Captured with the Phoenix ICON (100° field of view) · wide-field fundus photograph from neonatal ROP screening: 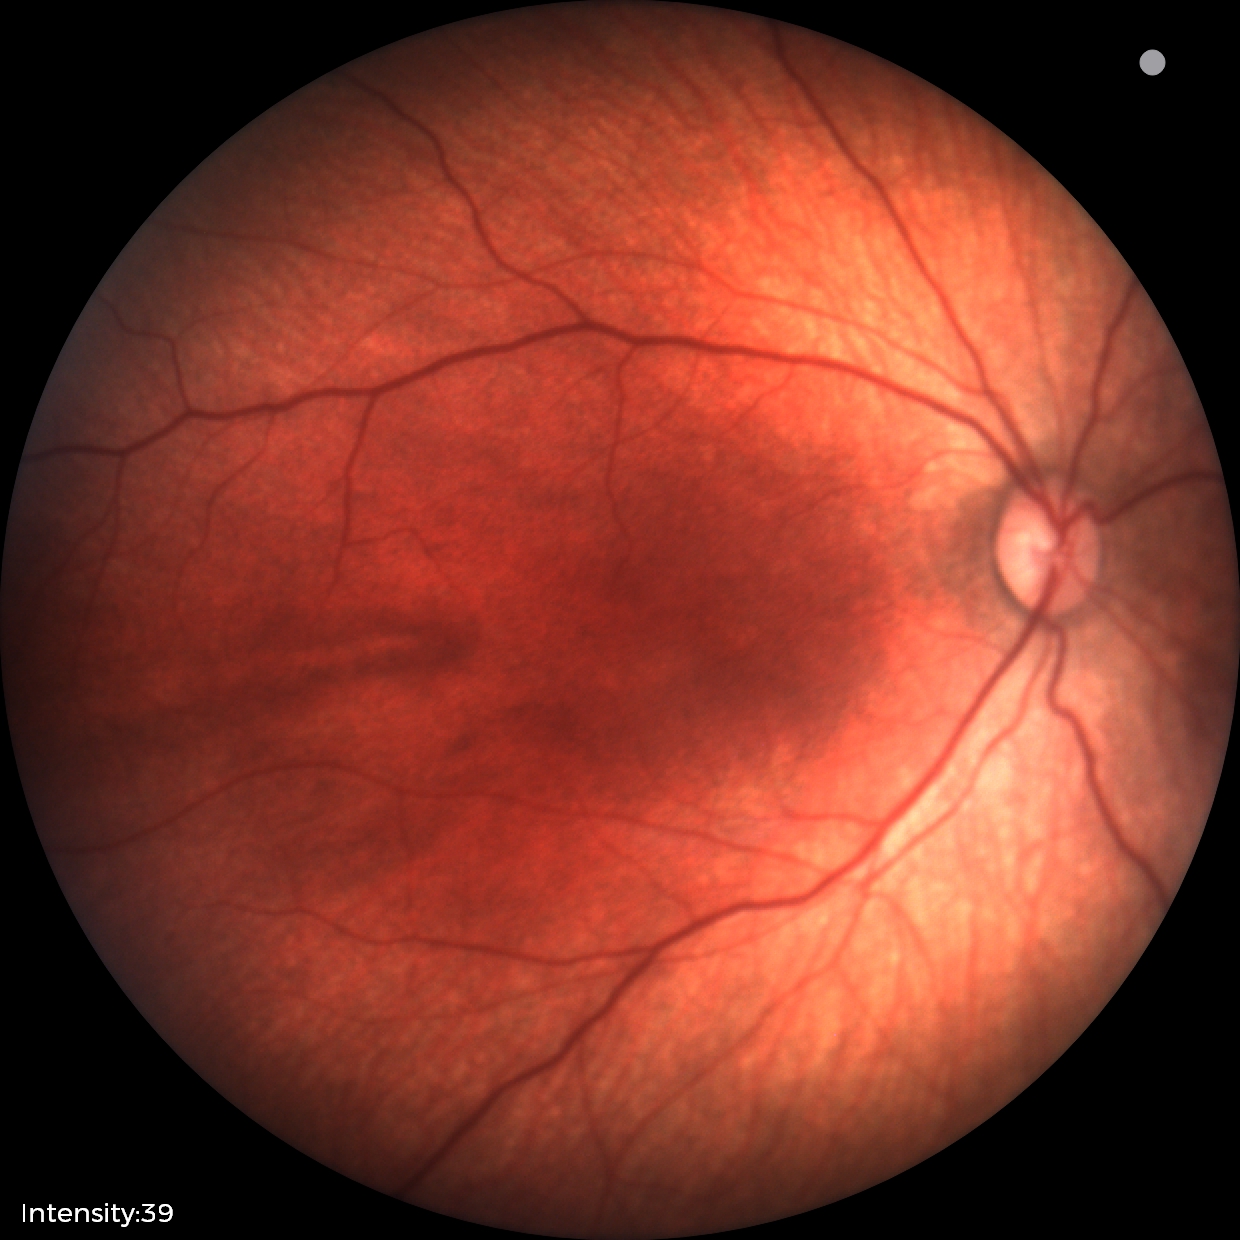

Physiological retinal appearance for postconceptual age.